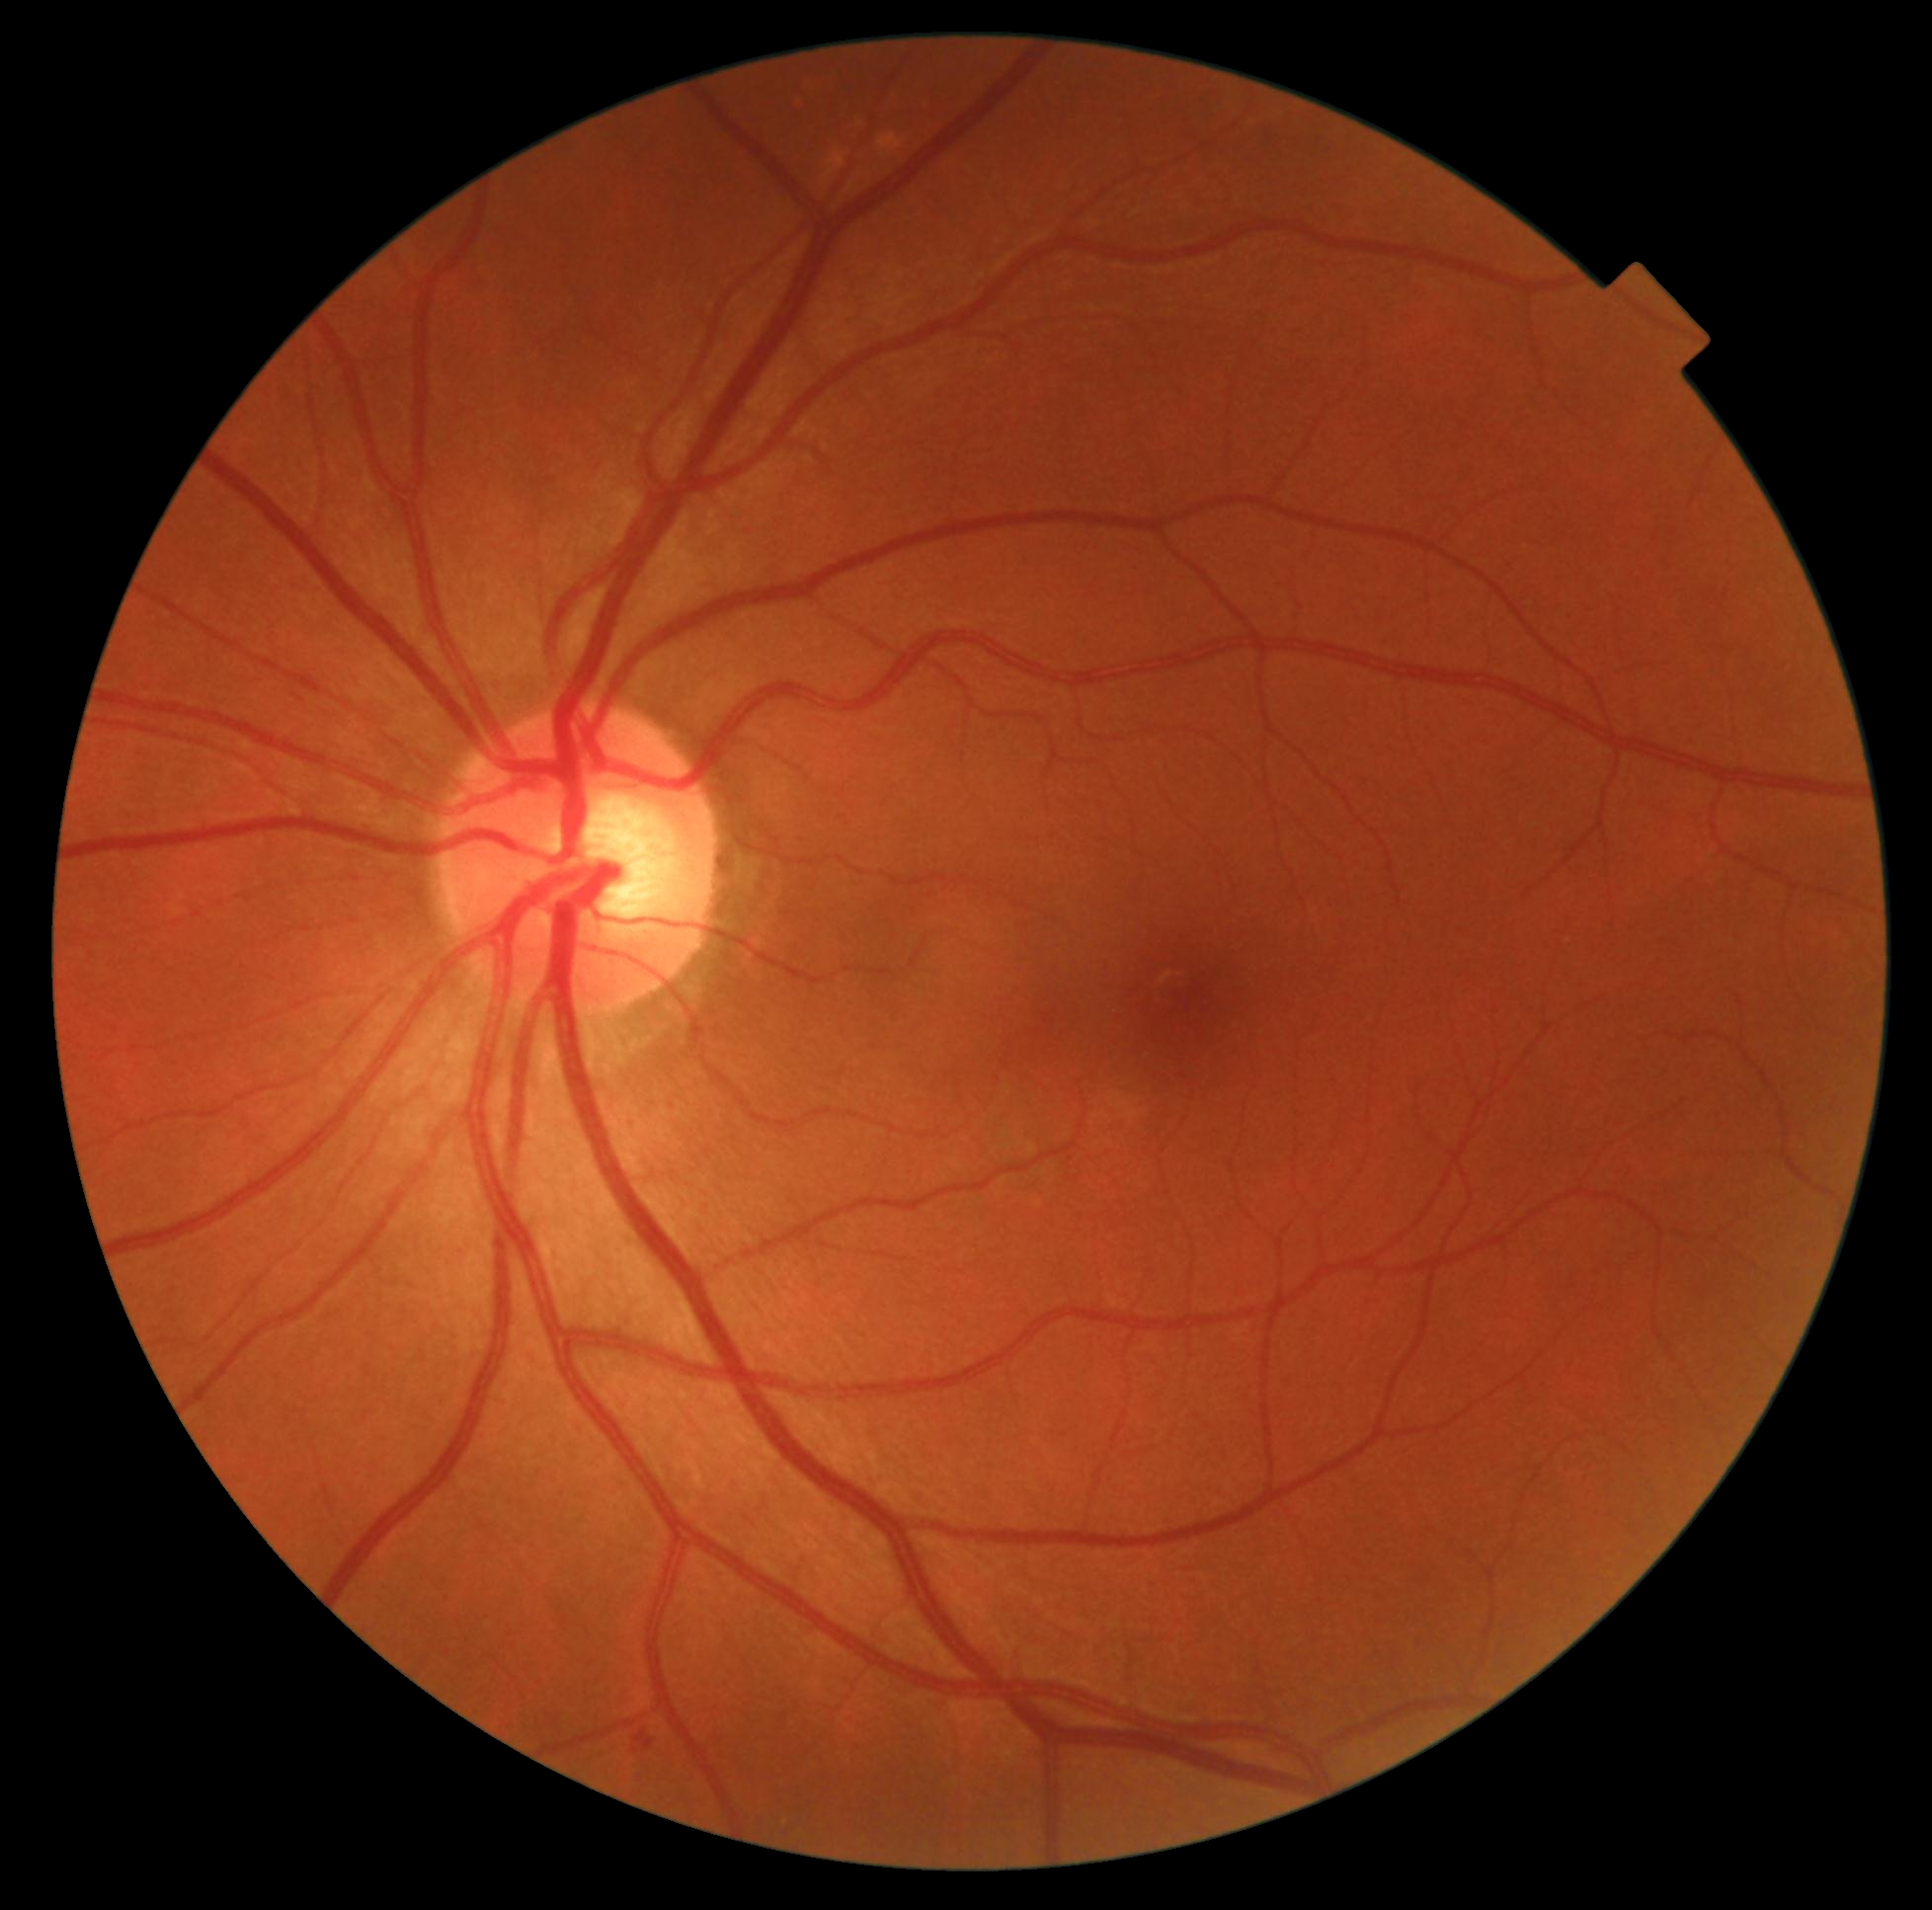 Diabetic retinopathy (DR) is 2.